1624x1232, fundus photo — 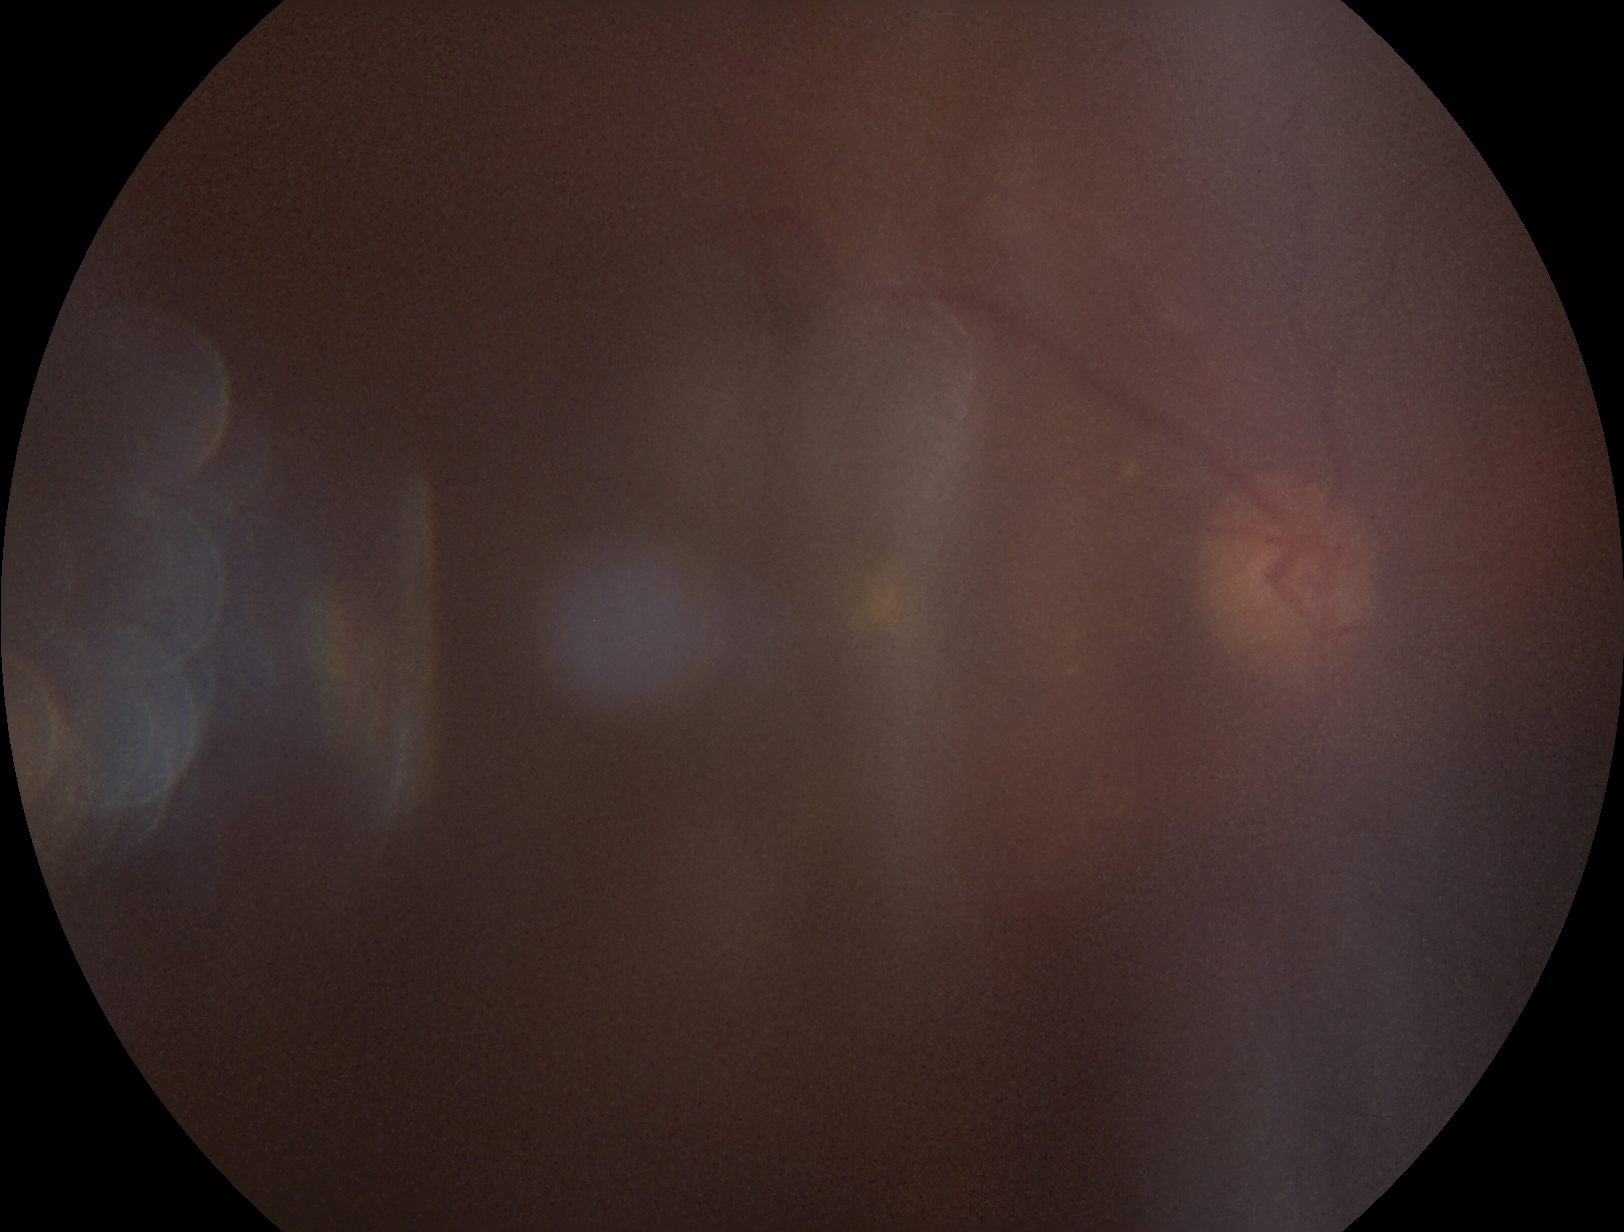 image quality = below grading threshold | DR severity = ungradable due to poor image quality.